CFP.
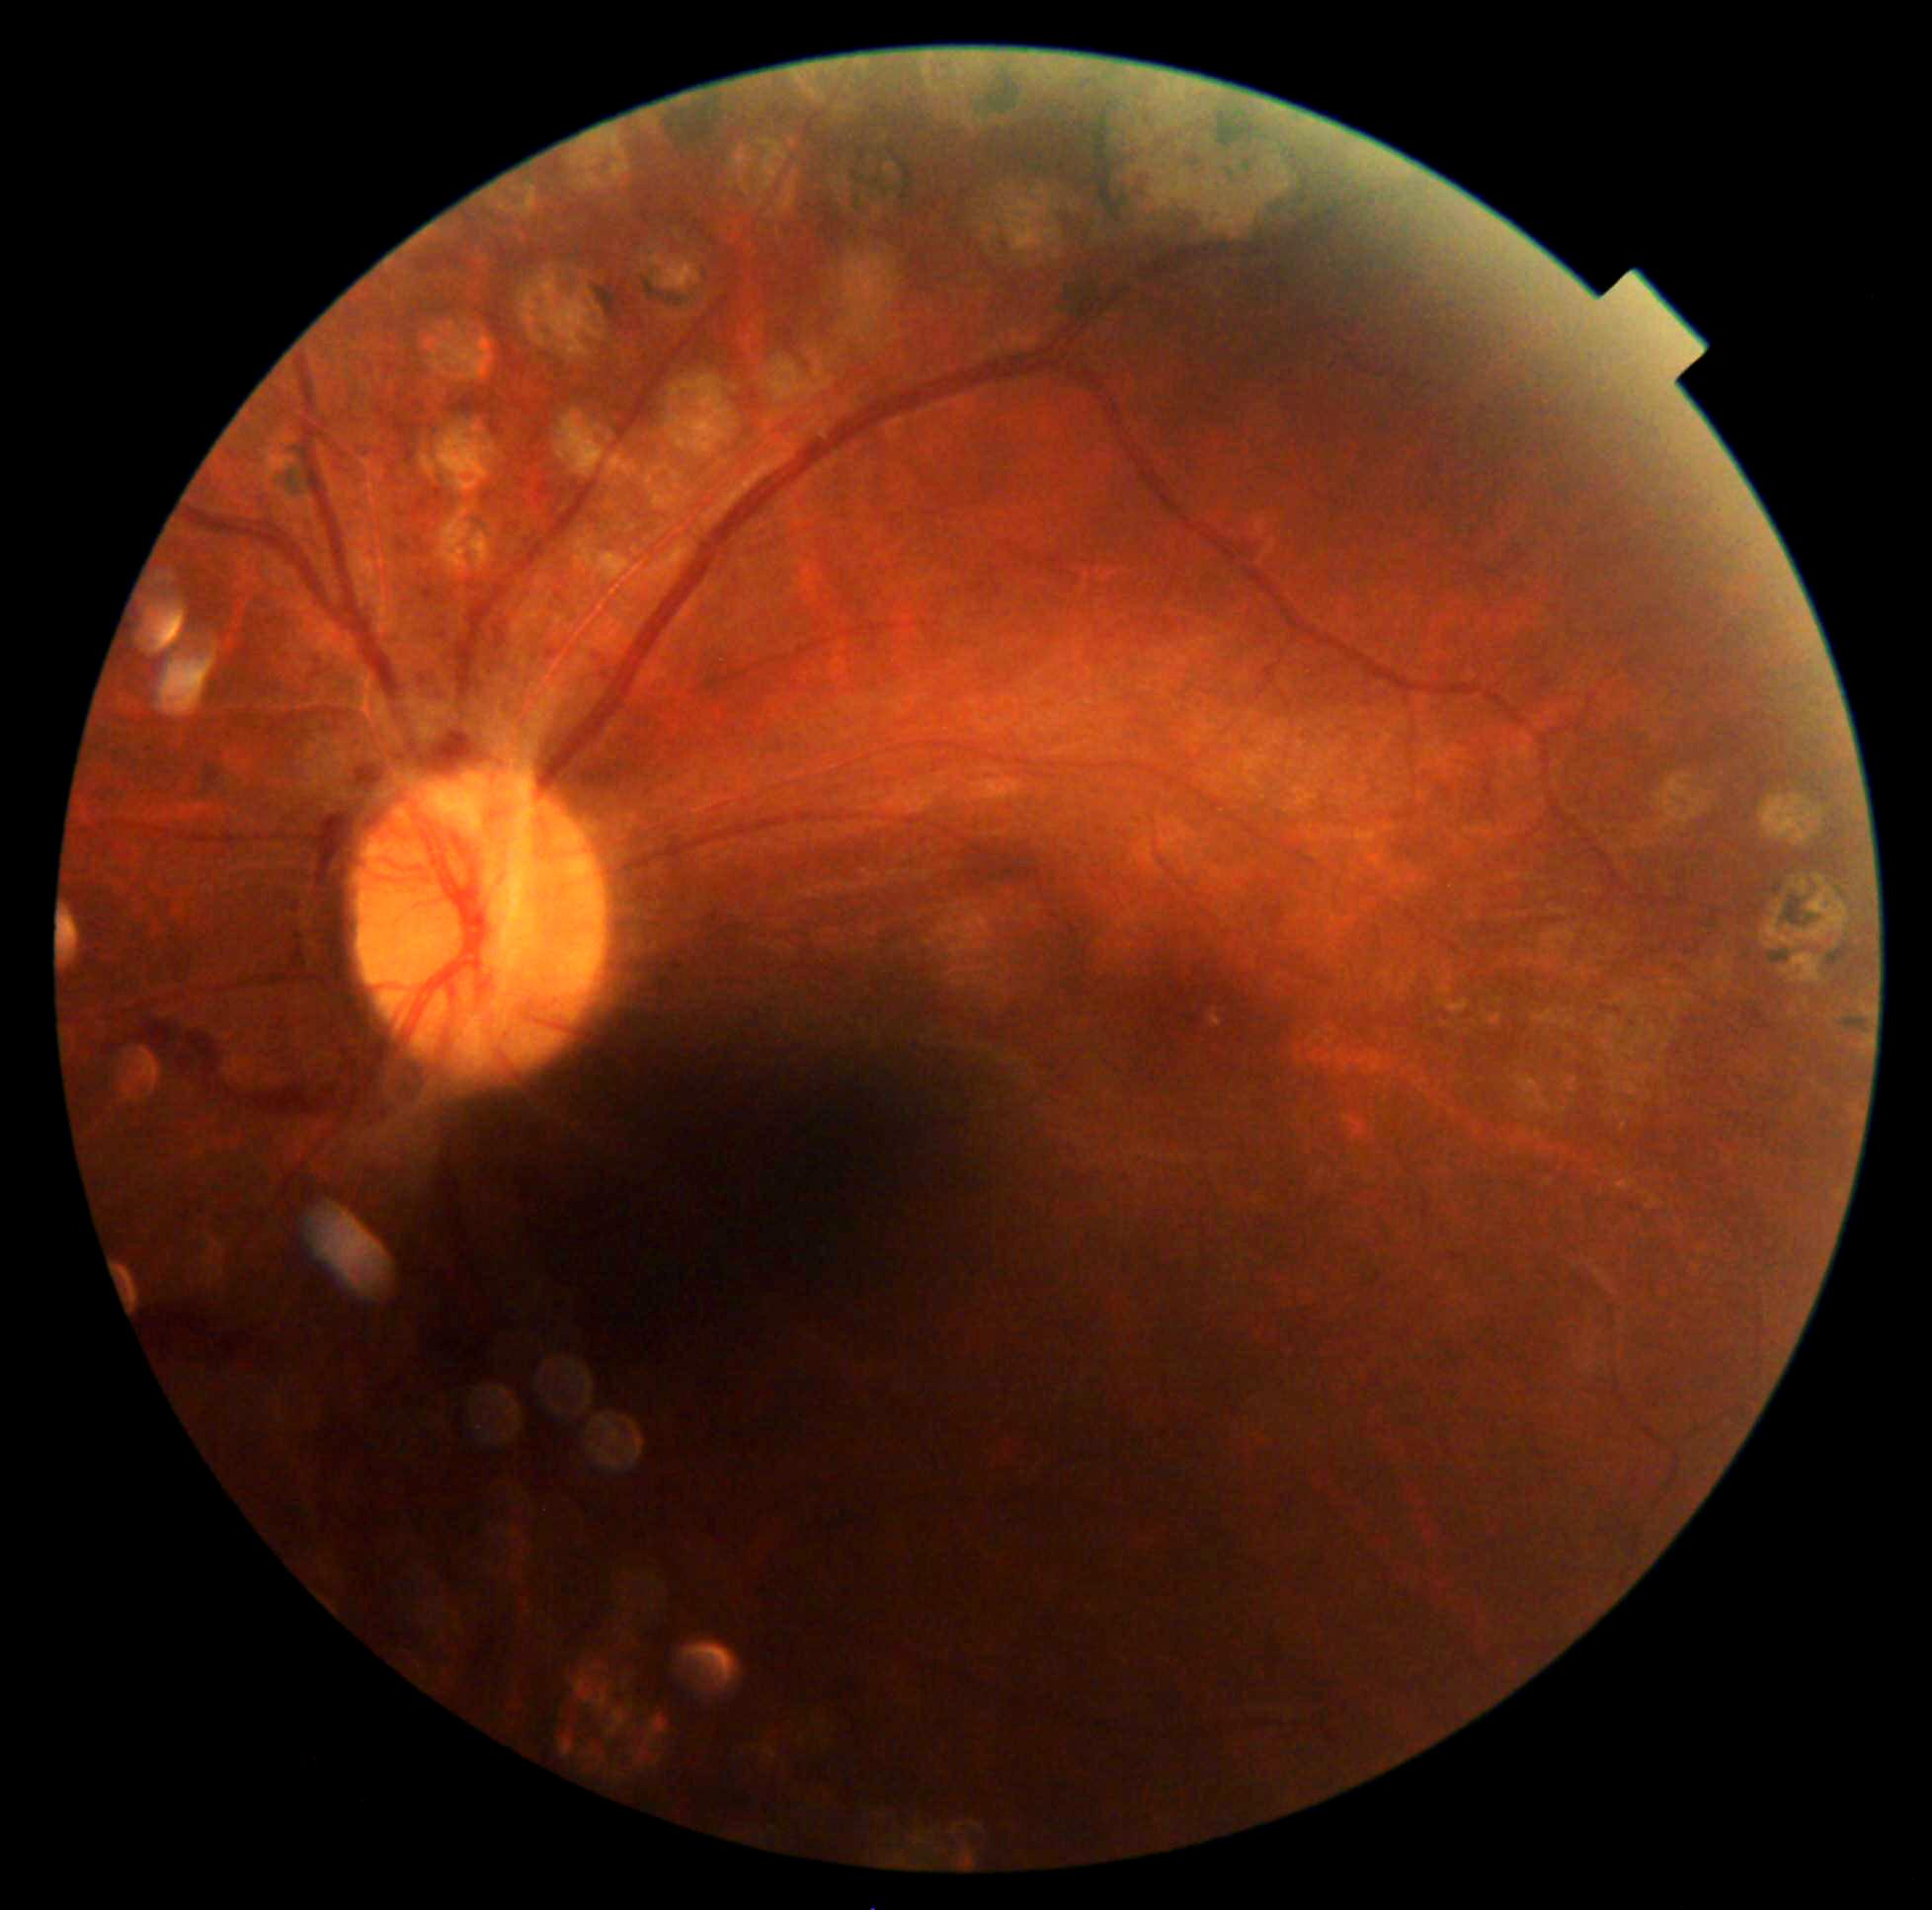 Diabetic retinopathy (DR): PDR (grade 4).